Retinal fundus photograph: 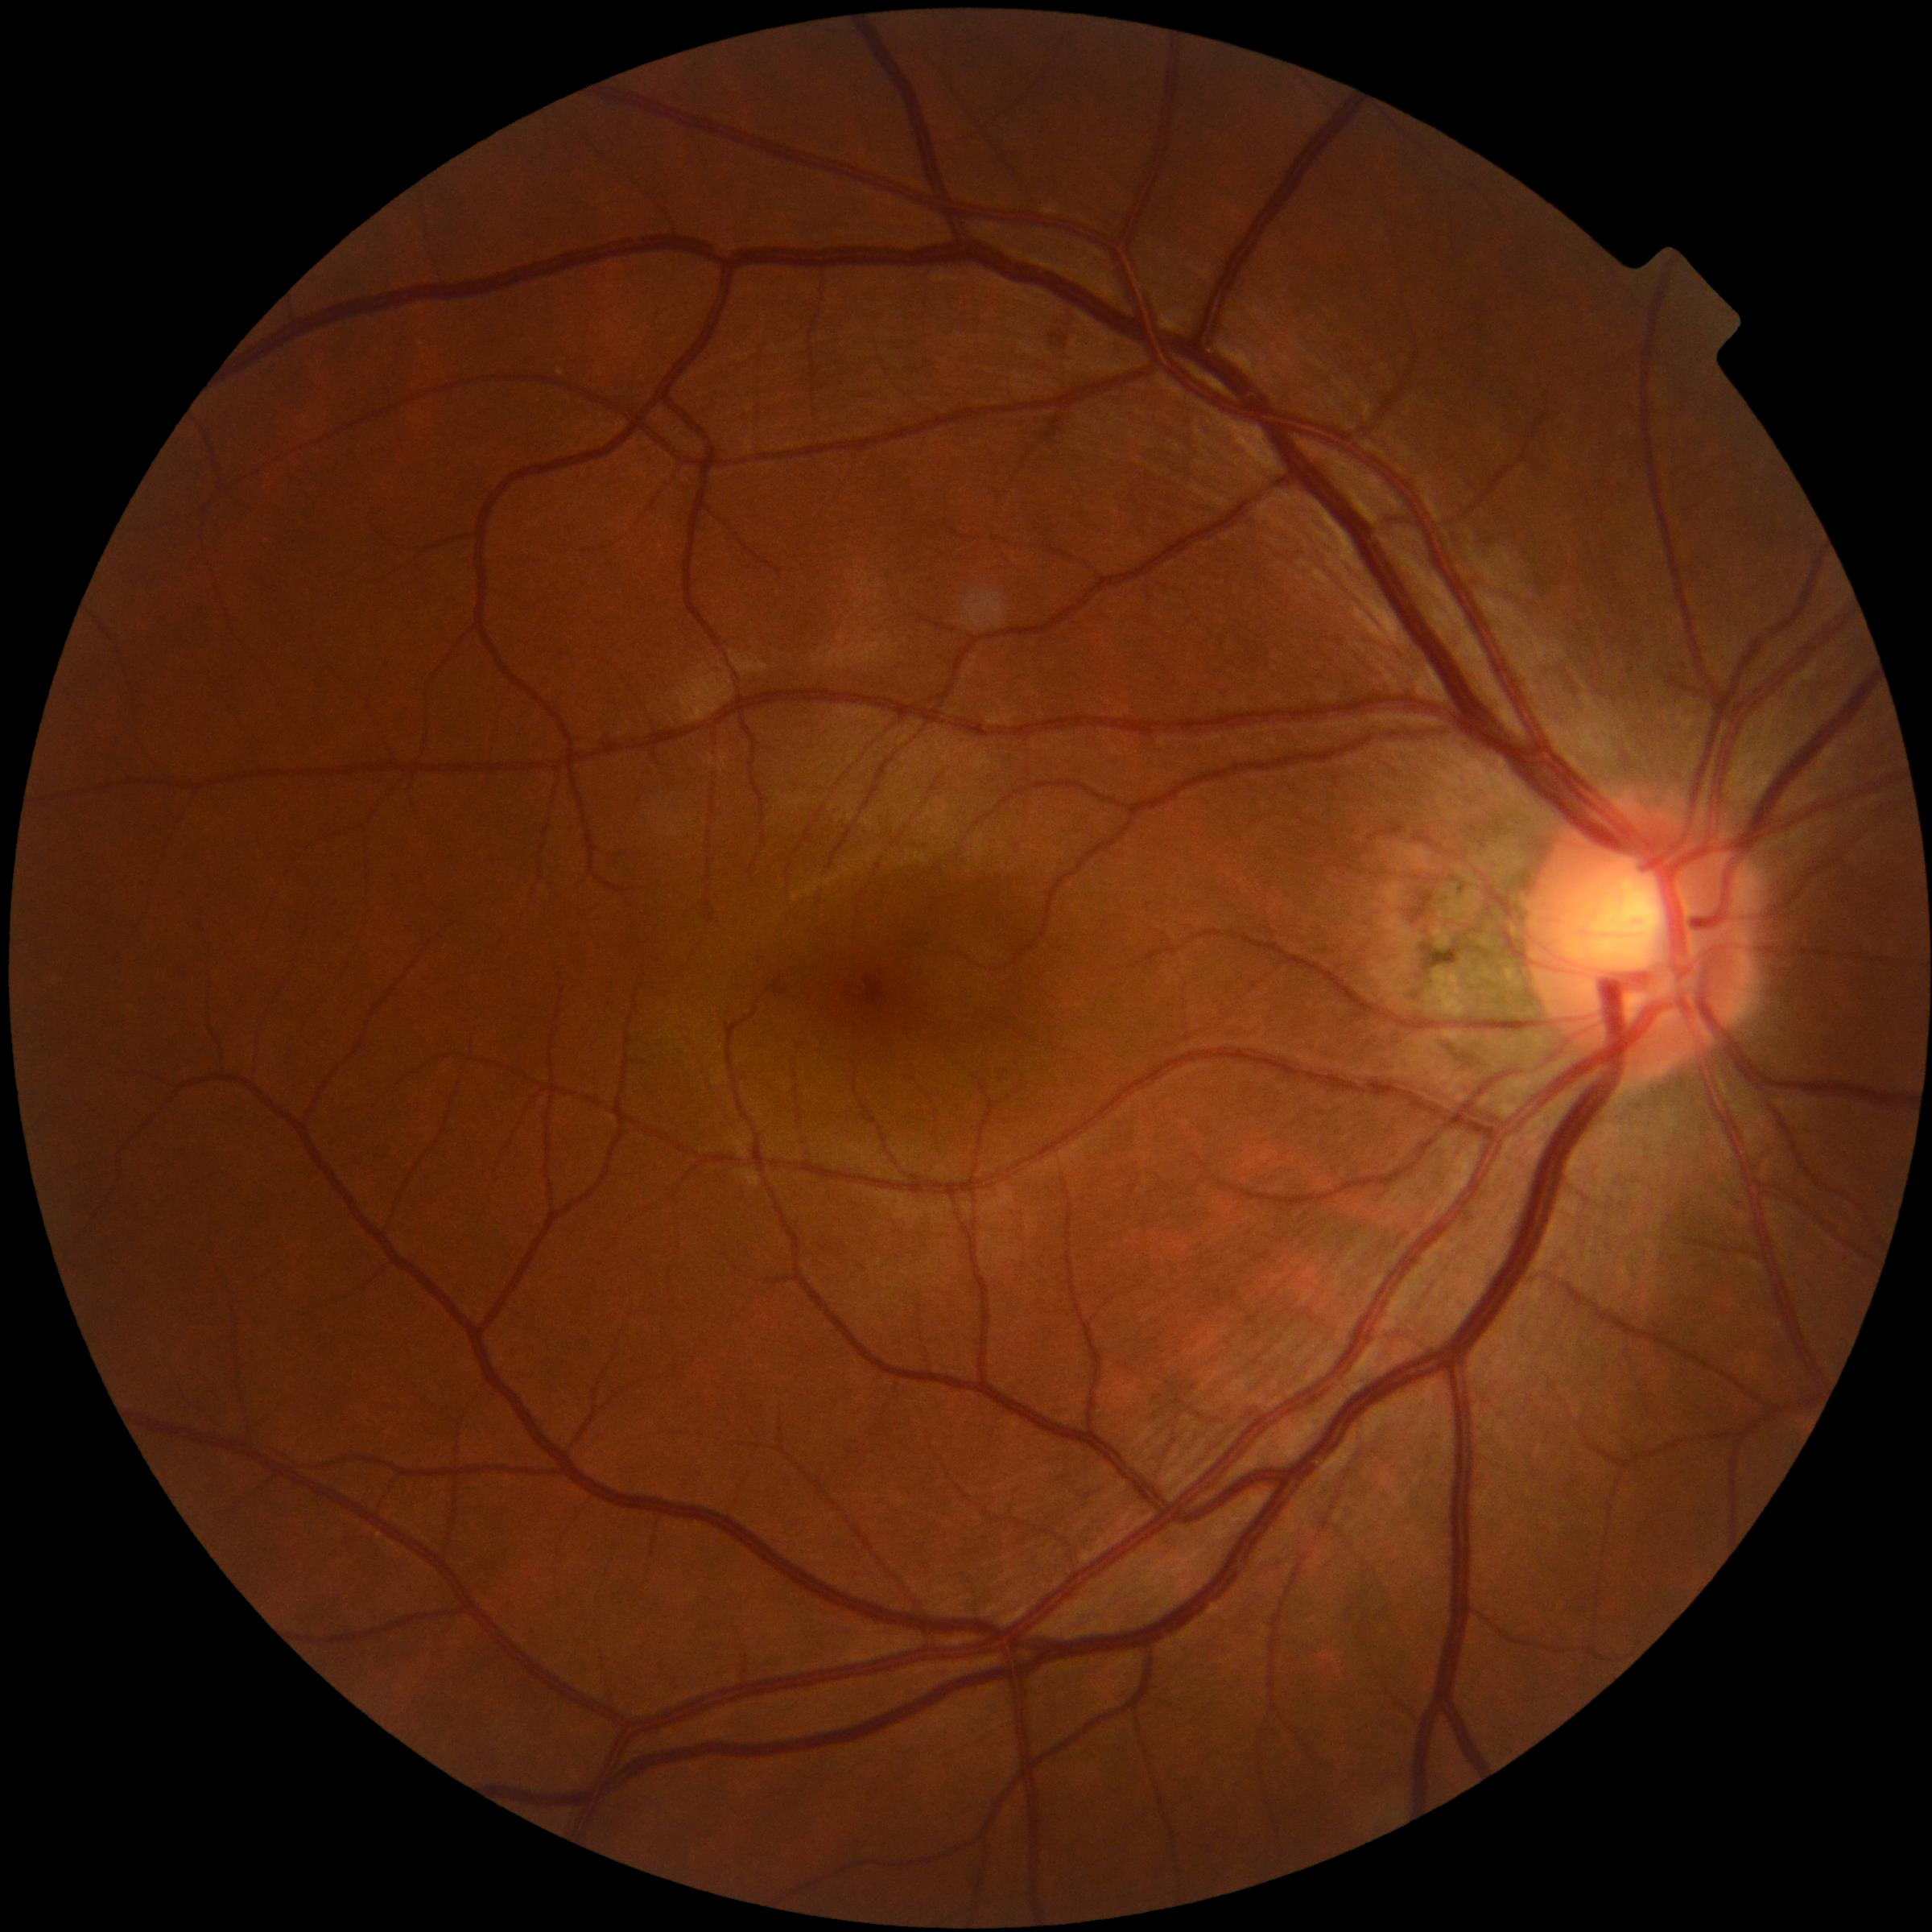

Retinopathy grade: no apparent retinopathy (0).